45° field of view
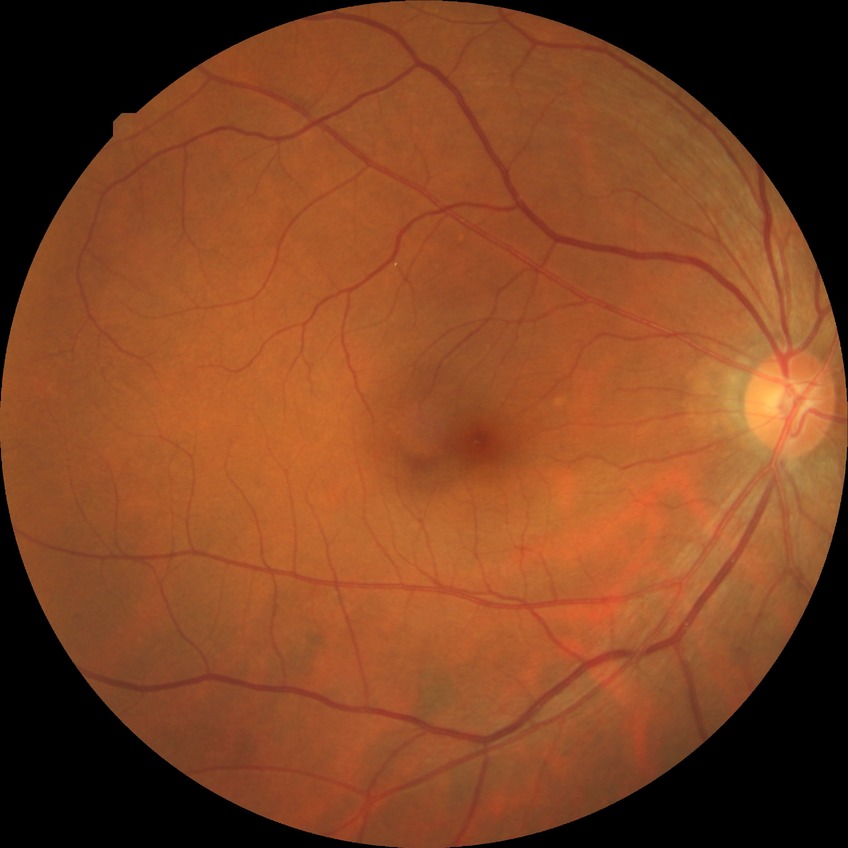

diabetic retinopathy grade: simple diabetic retinopathy.